2184 by 1690 pixels, CFP, 45-degree field of view: 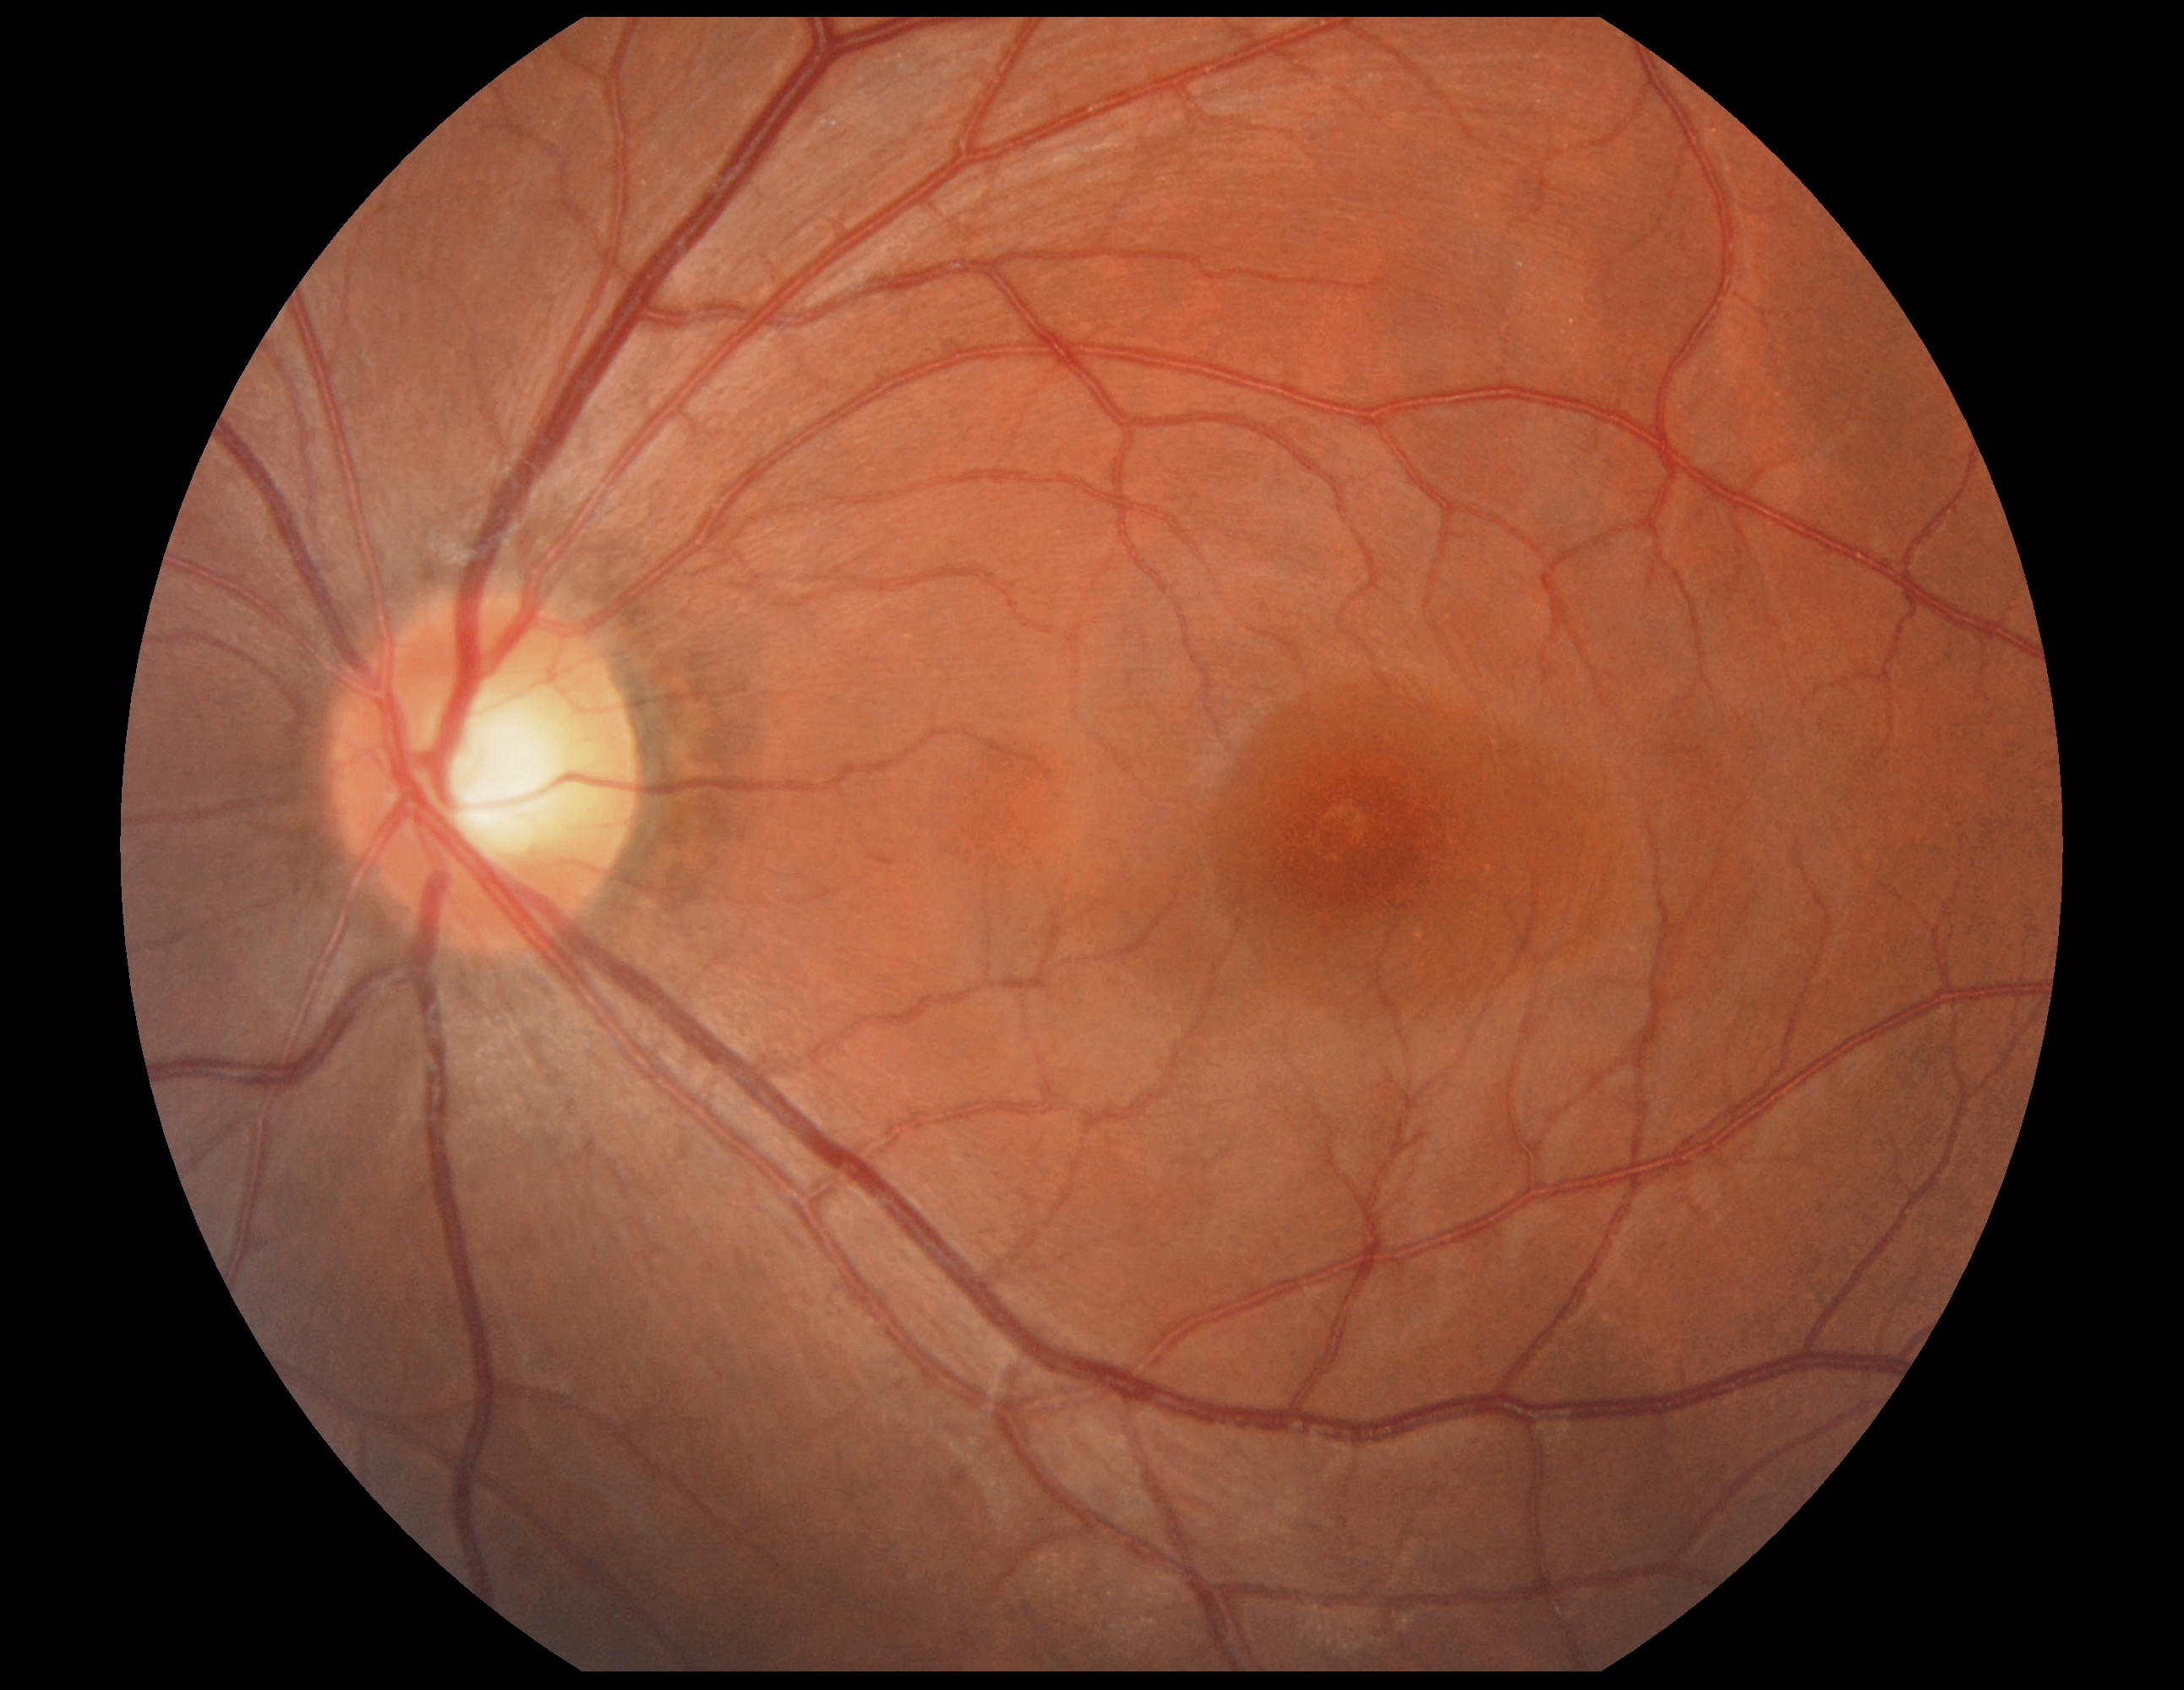 DR grade=0 (no apparent retinopathy) — no visible signs of diabetic retinopathy.